FOV: 45 degrees; nonmydriatic:
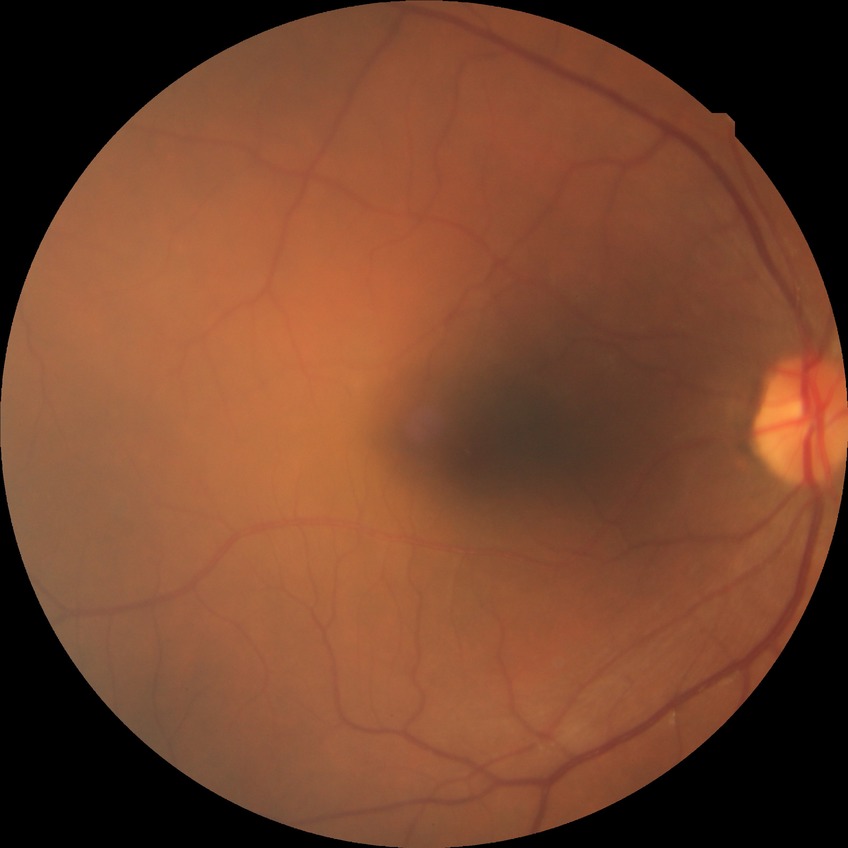
{"davis_grade": "no diabetic retinopathy (NDR)"}